Retinal fundus photograph, FOV: 45 degrees, 2048 x 1536 pixels — 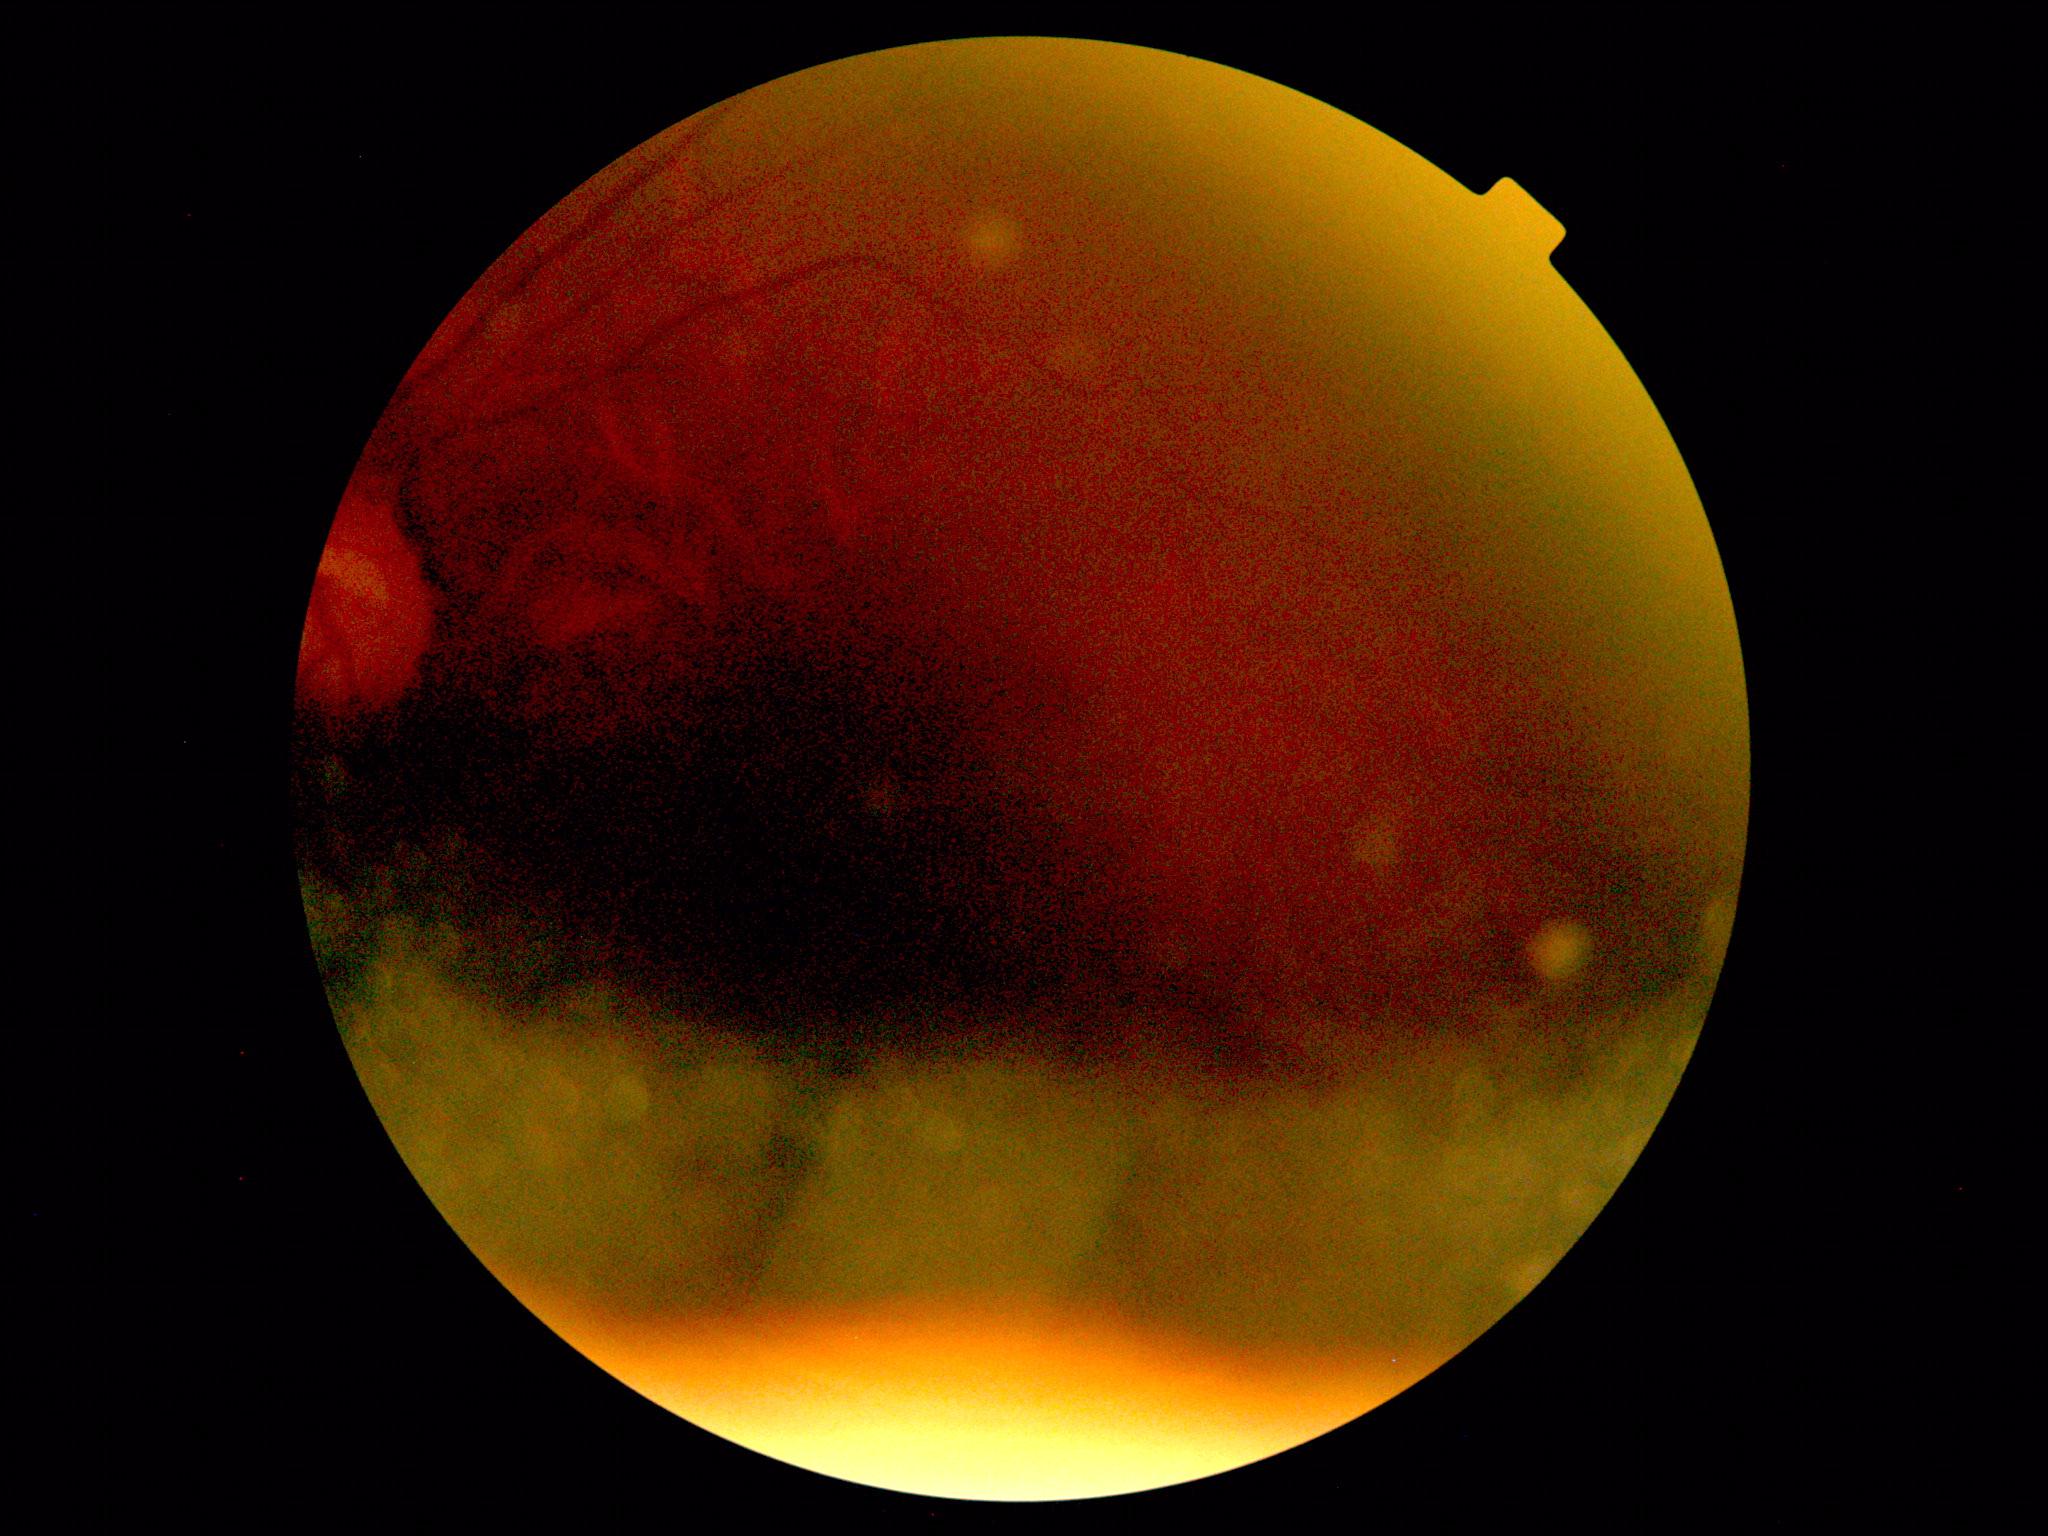
Image quality is insufficient for diabetic retinopathy assessment.
Diabetic retinopathy (DR): ungradable due to poor image quality.